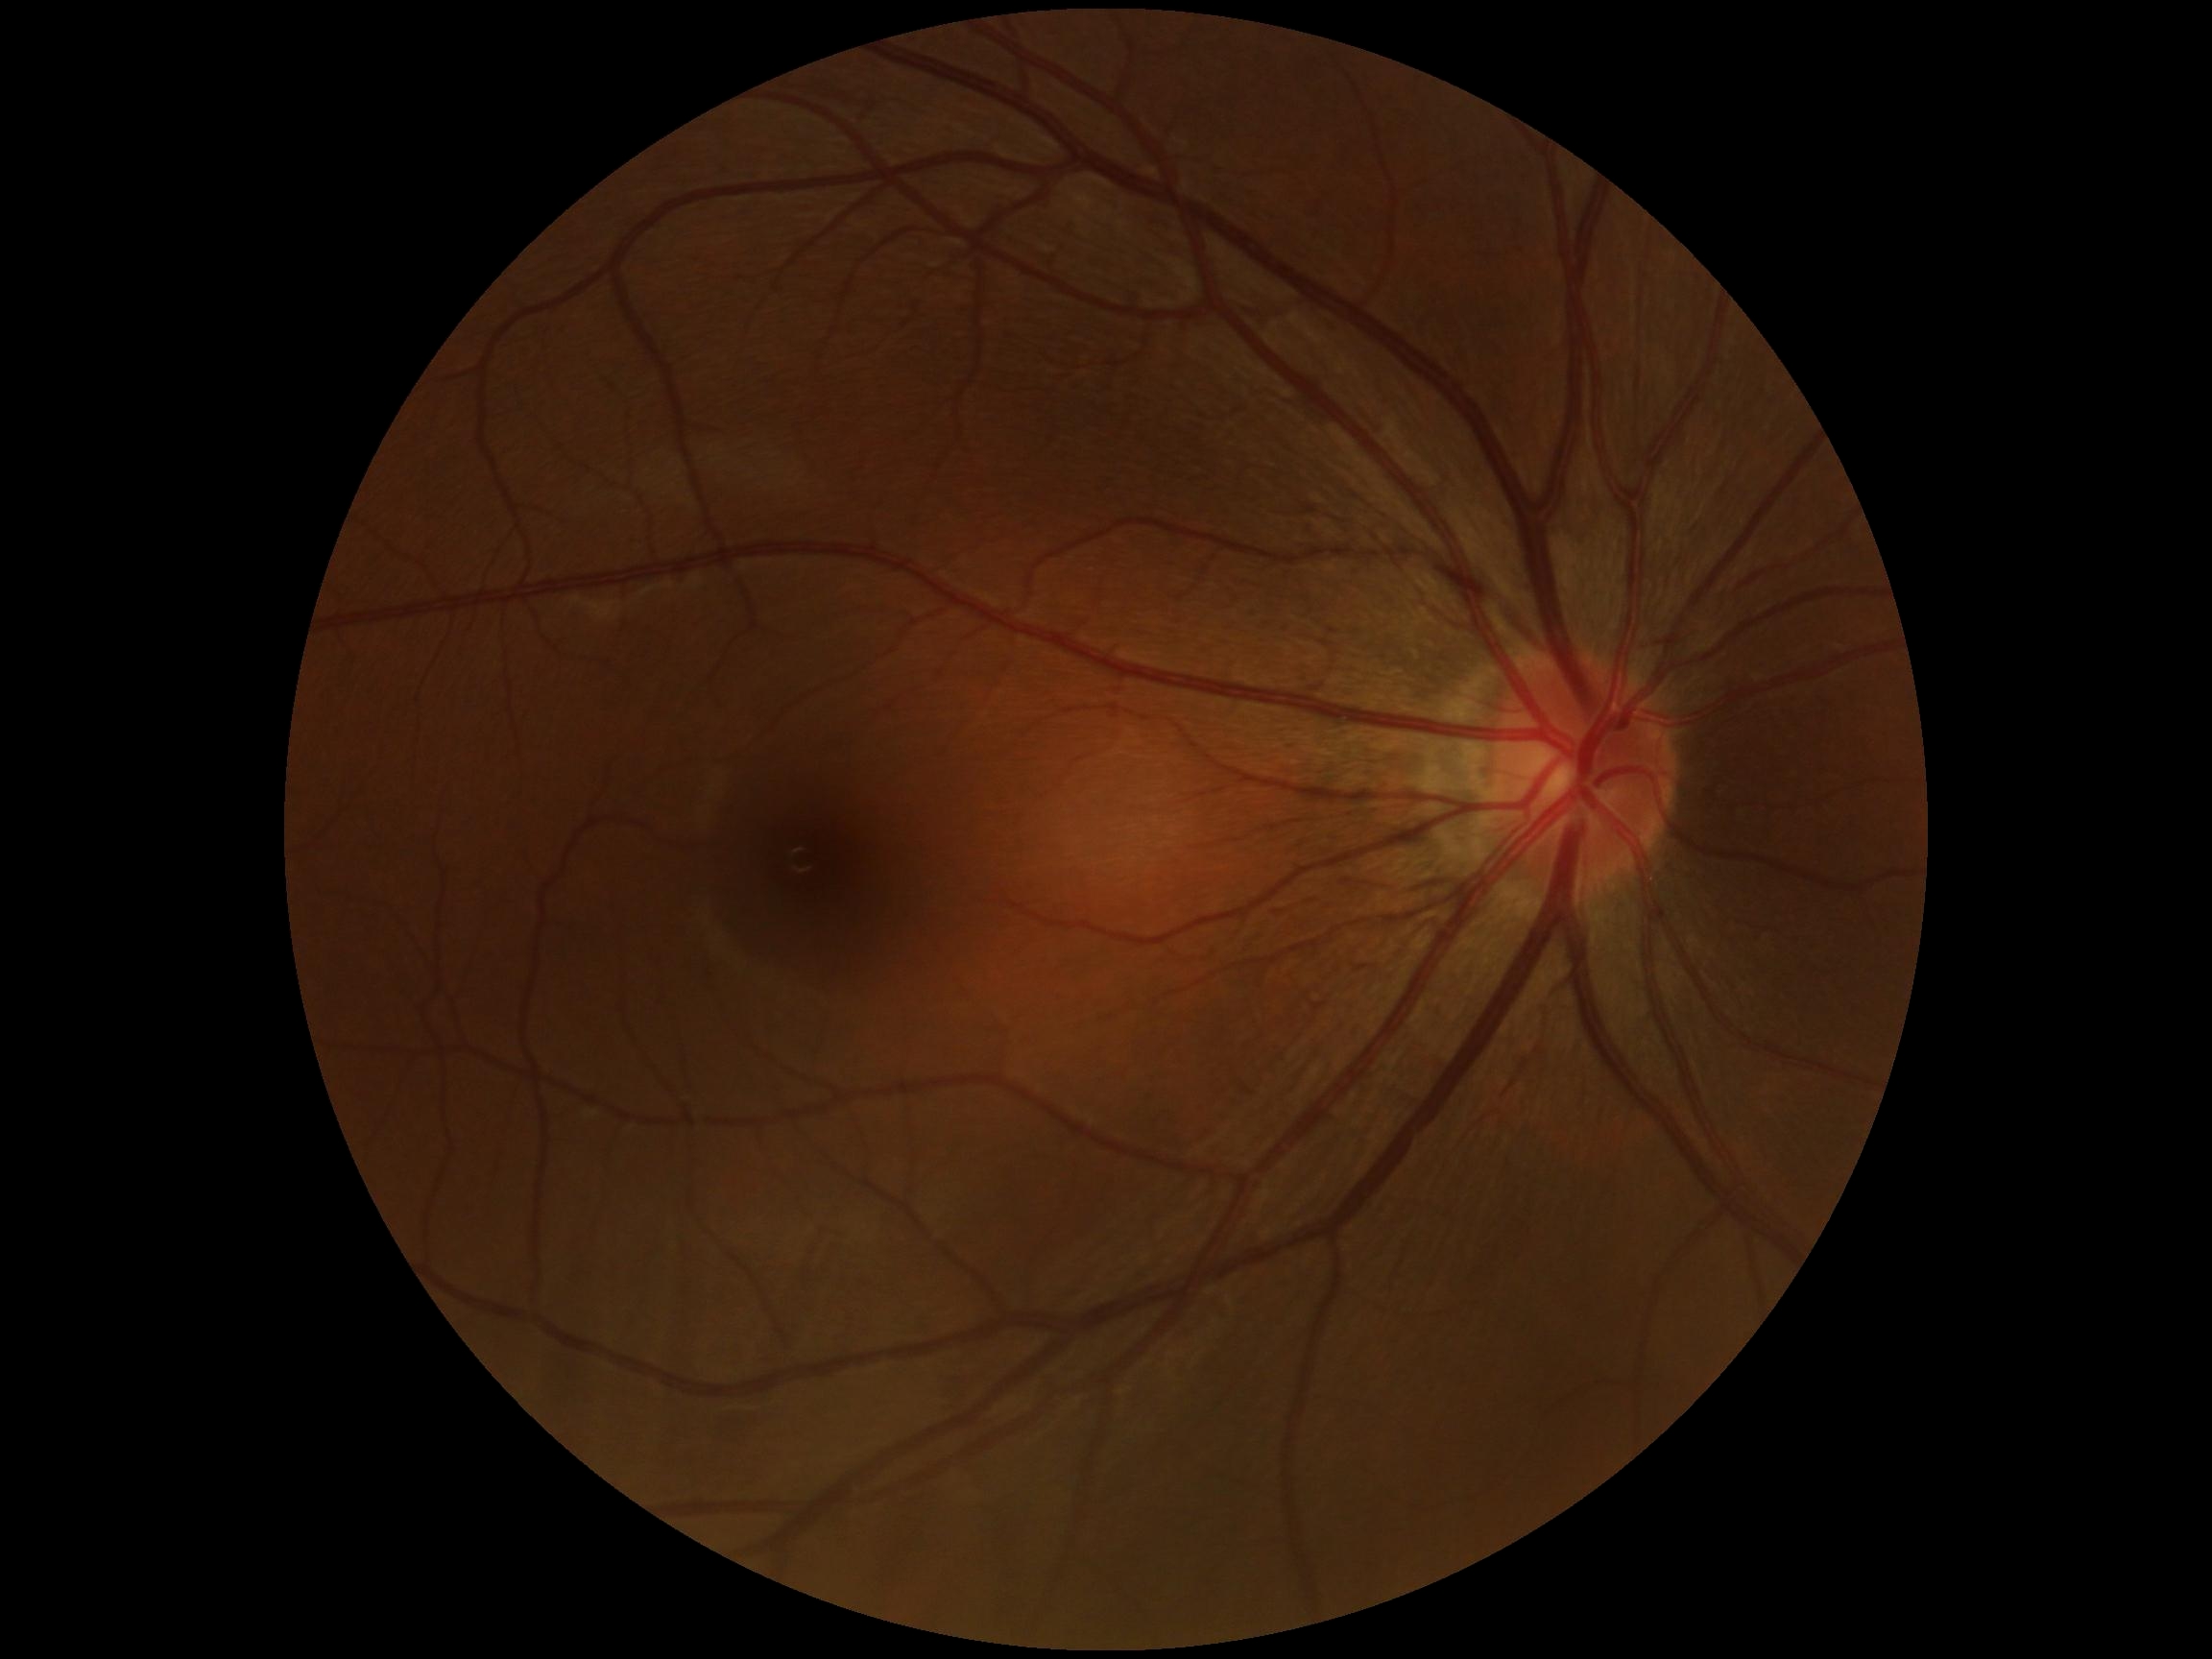
{"dr_grade": "0 (no apparent retinopathy) — no visible signs of diabetic retinopathy"}